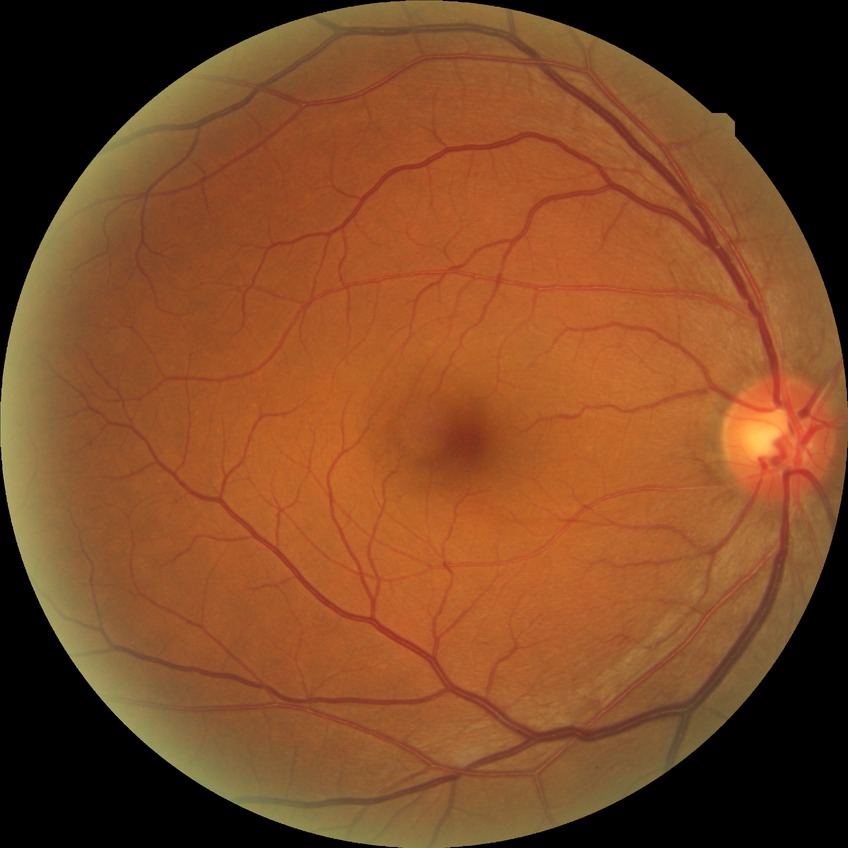
DR impression: no DR findings | Davis DR grade: NDR.